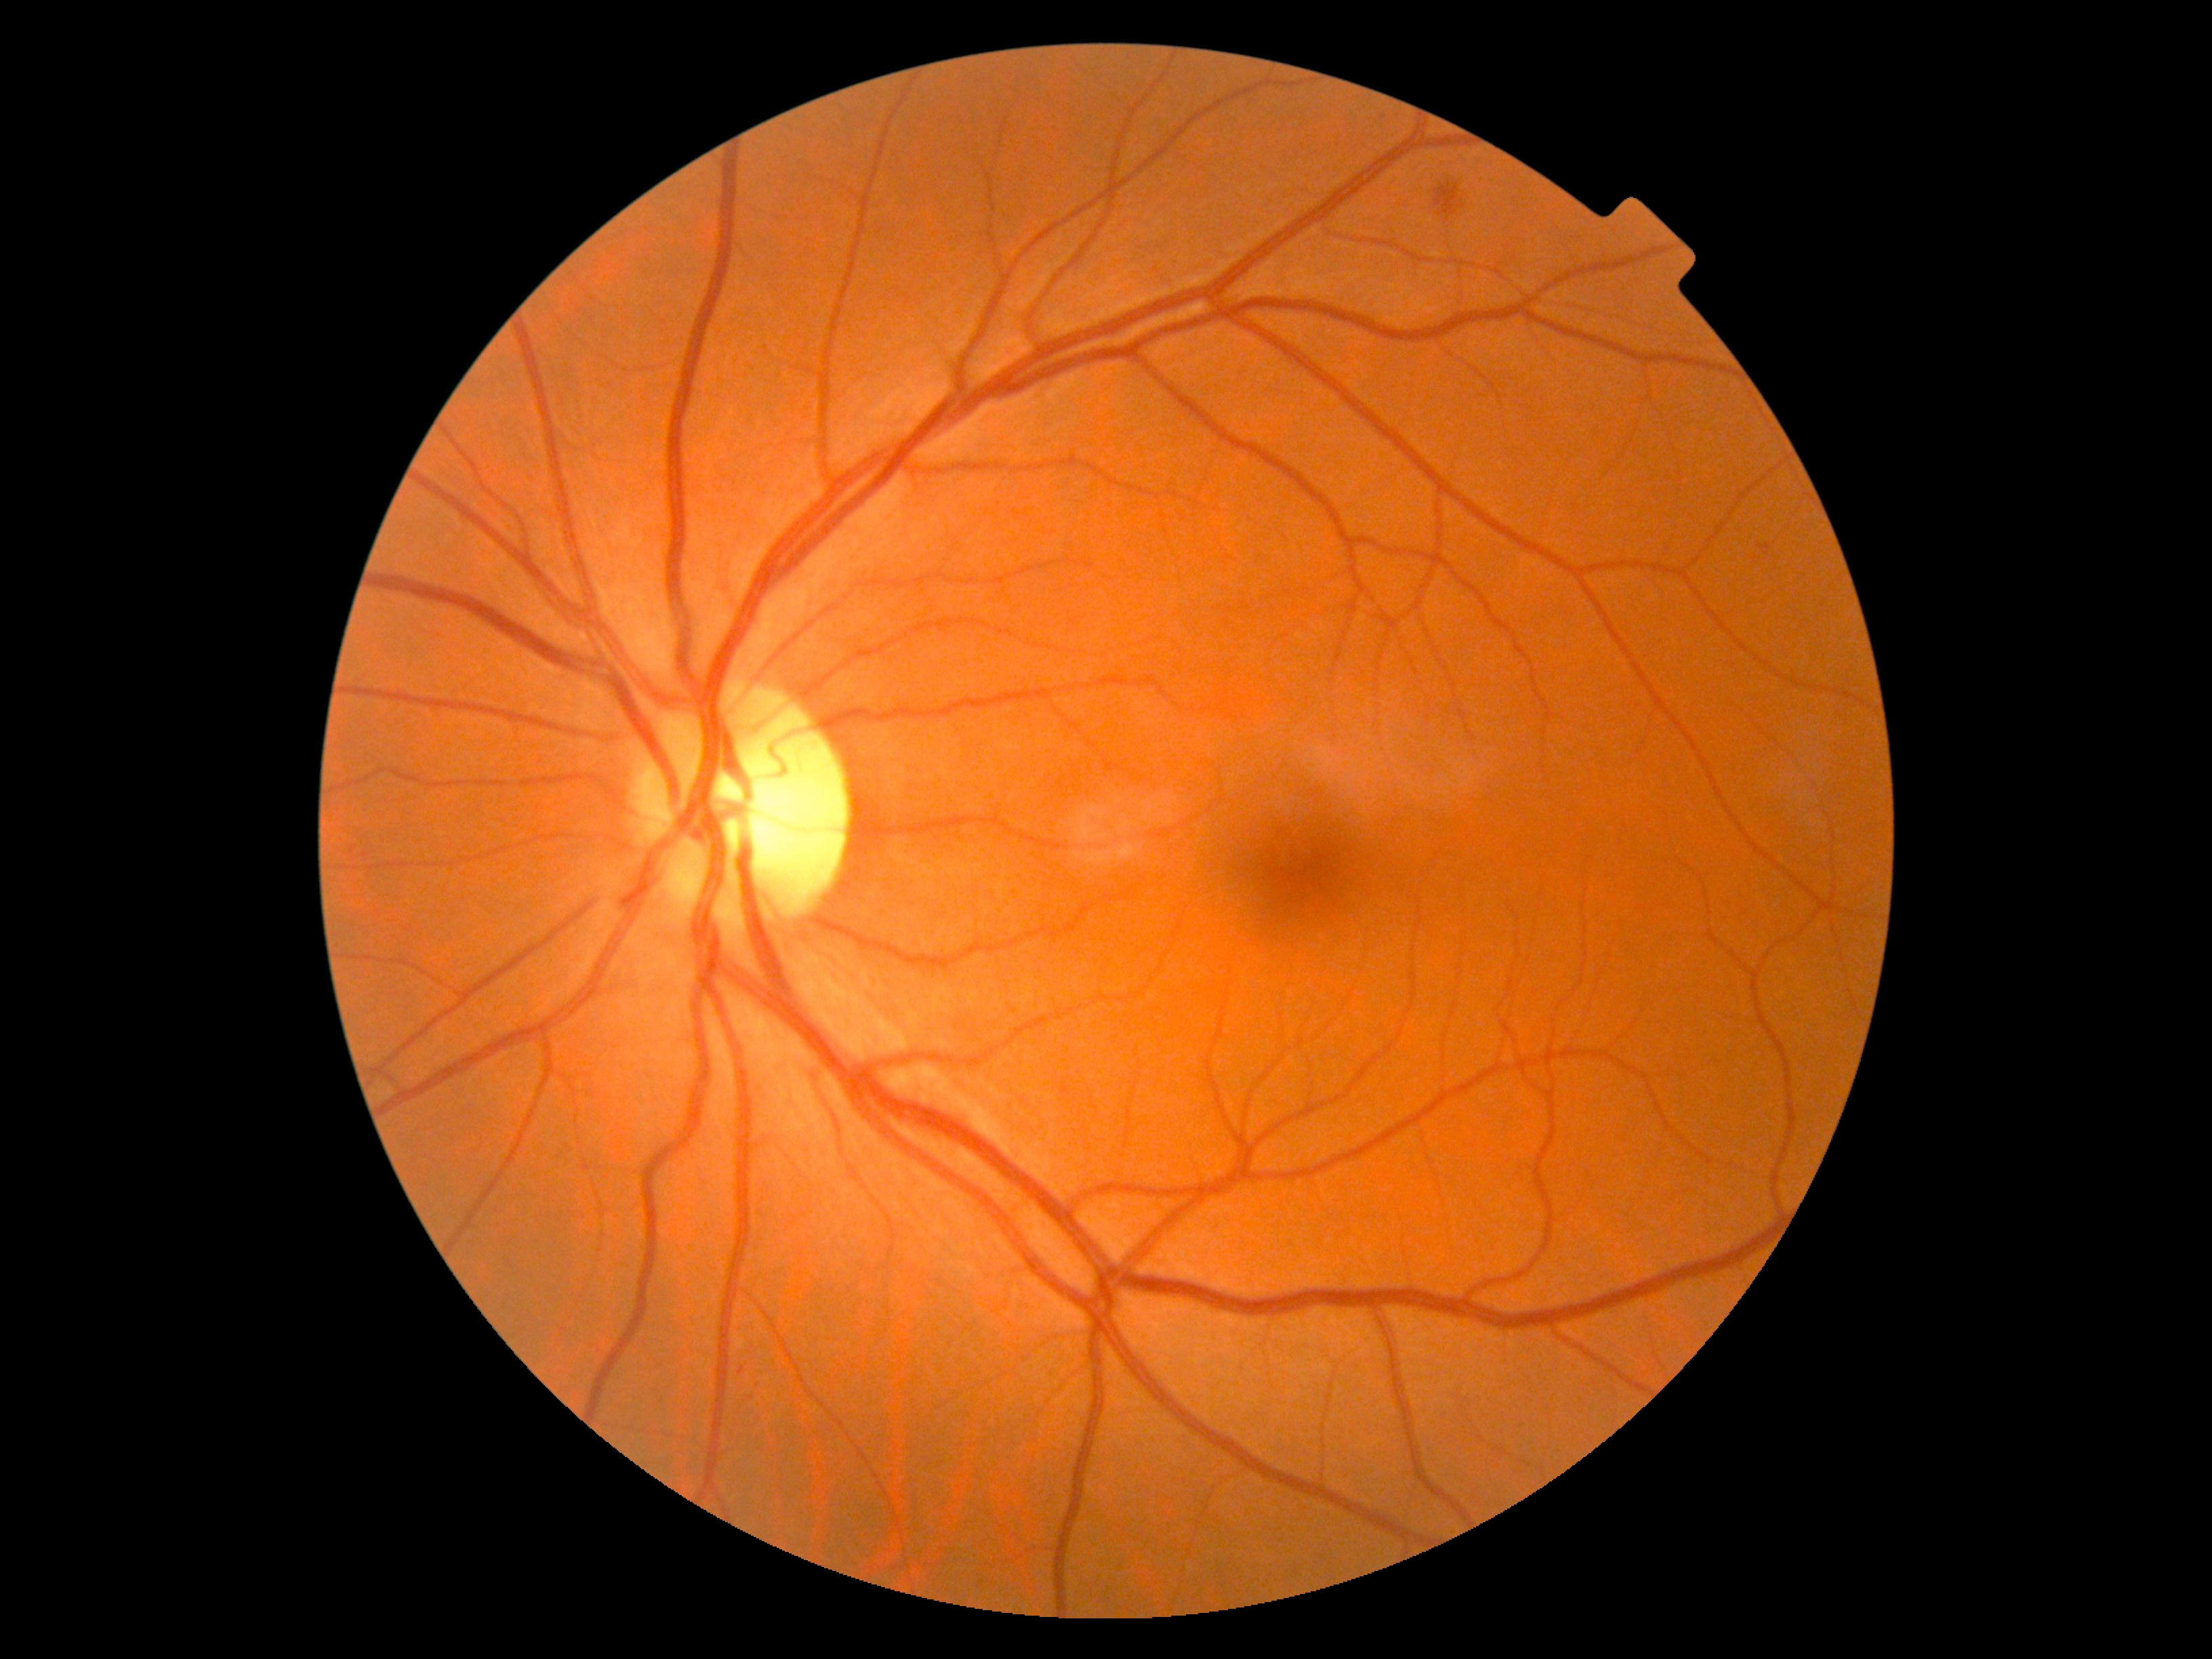

Annotations:
* diabetic retinopathy (DR) — grade 2 (moderate NPDR)
* DR class — non-proliferative diabetic retinopathy